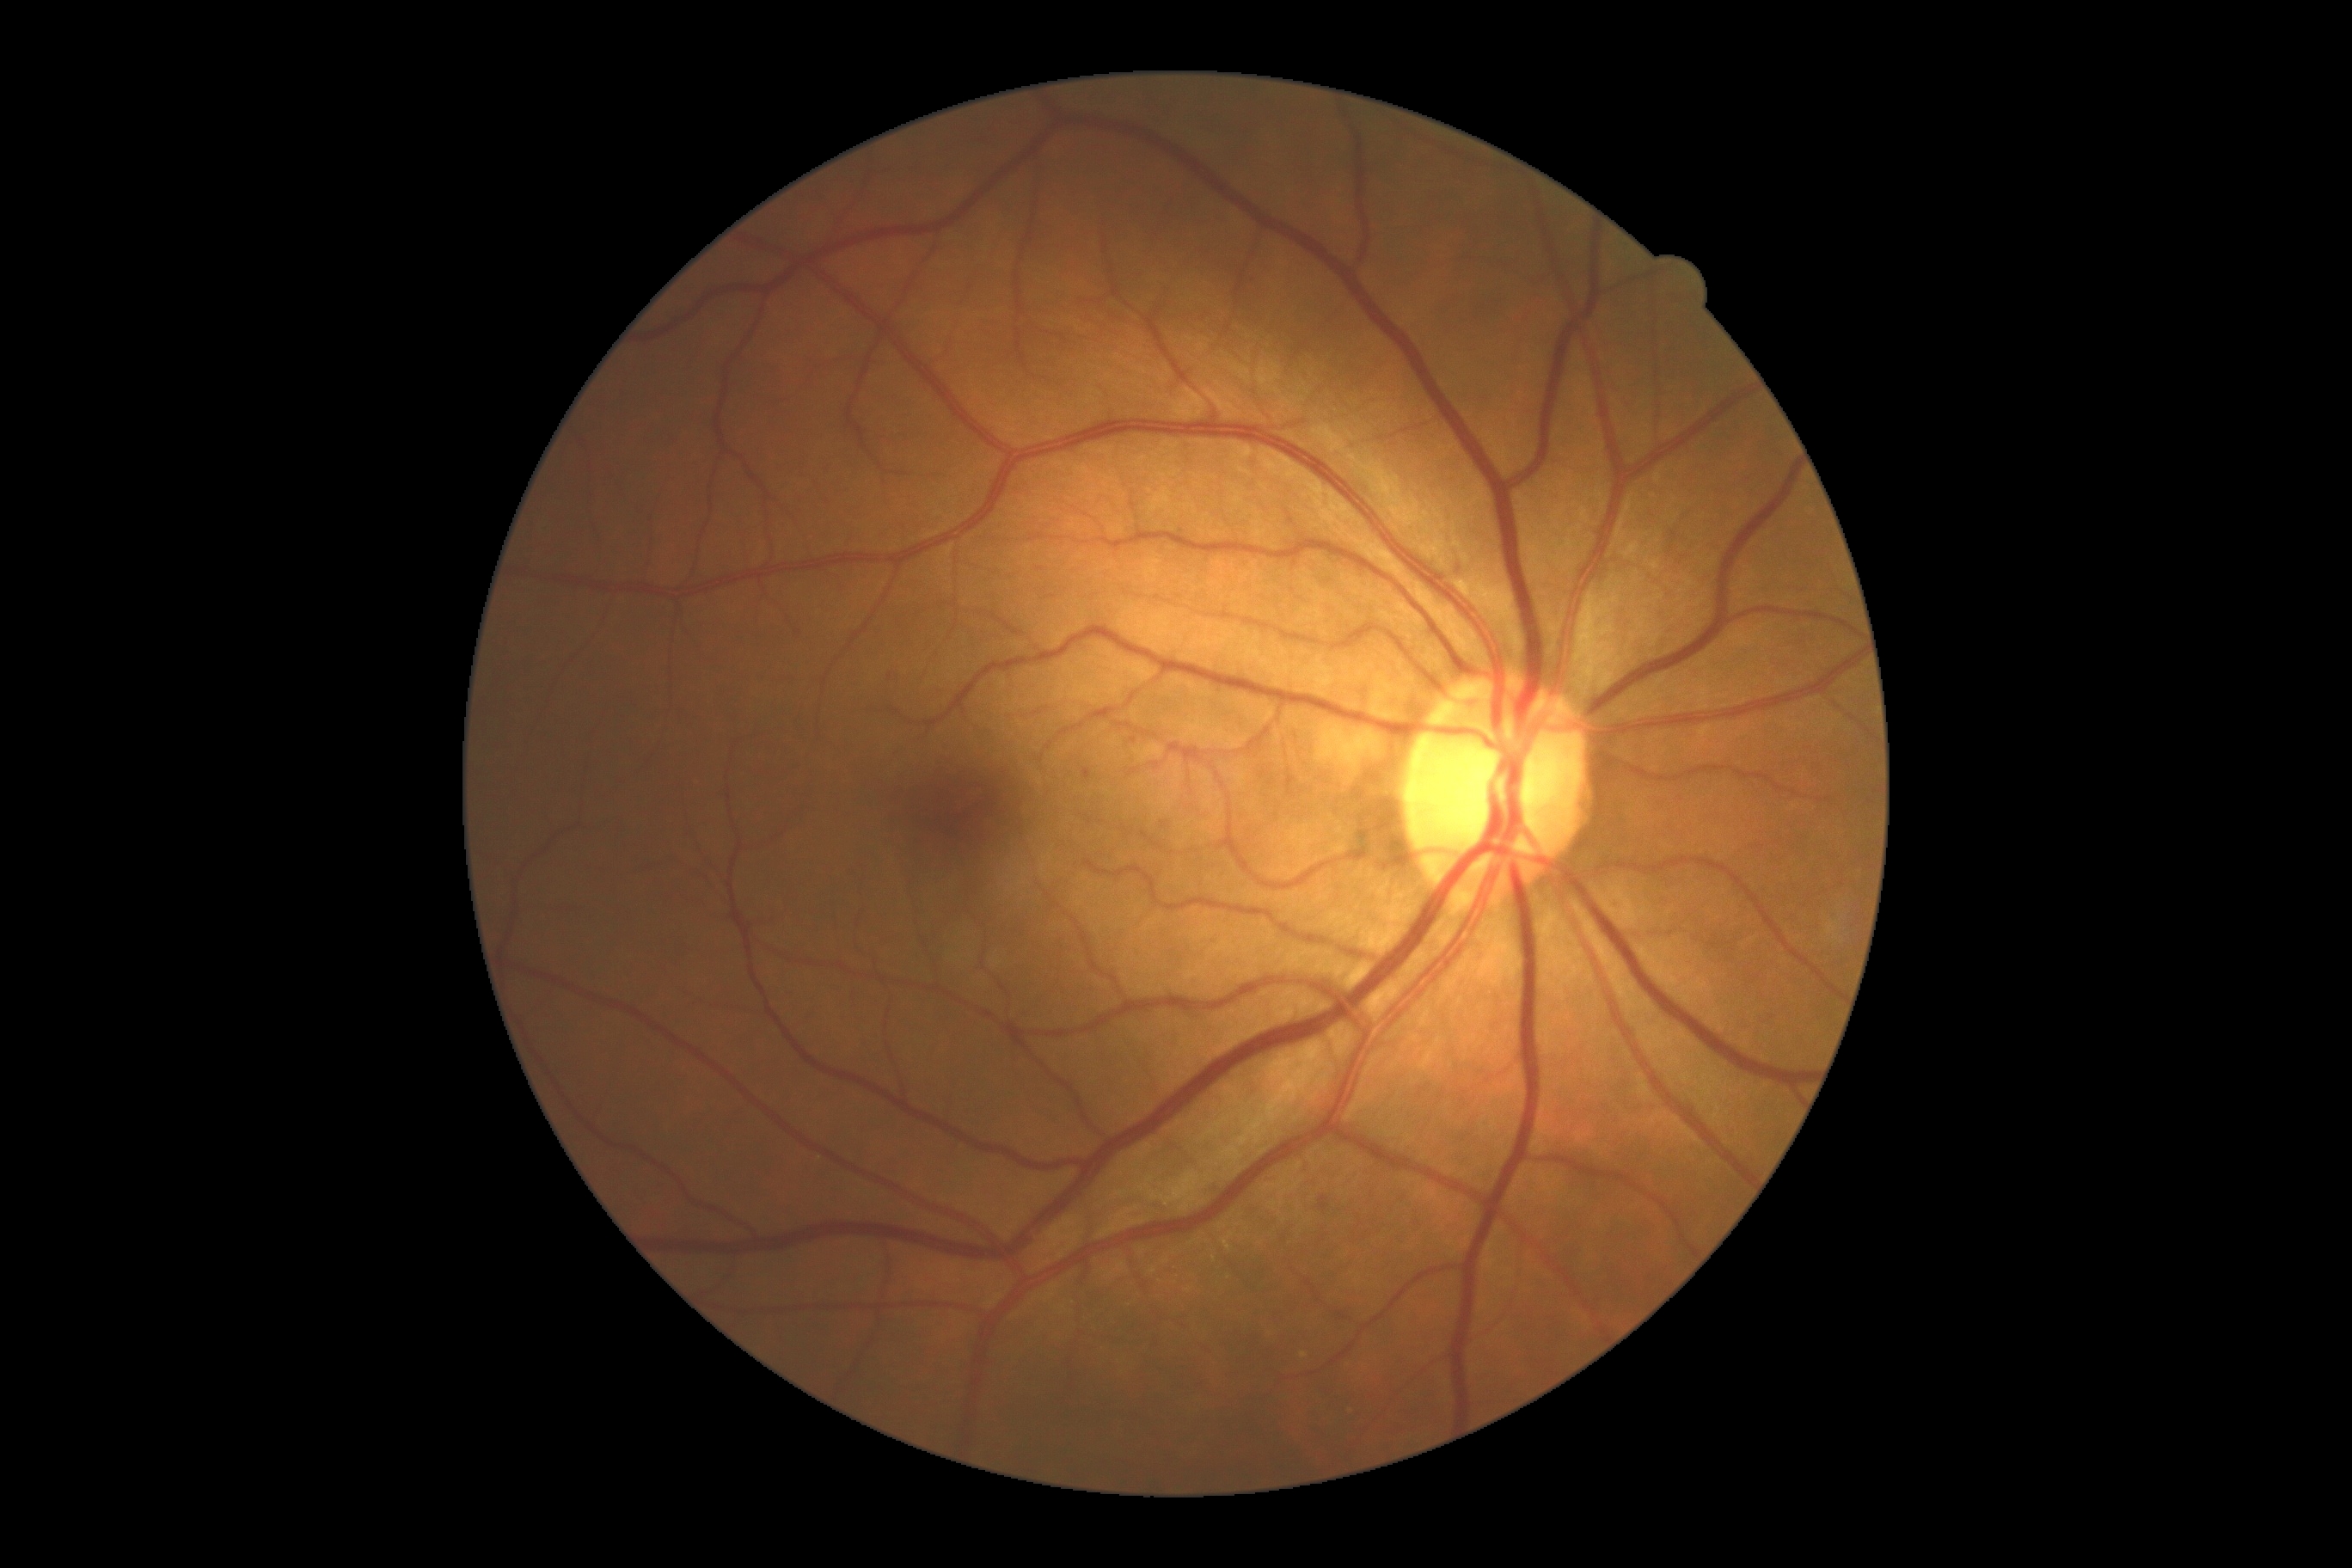

DR class: non-proliferative diabetic retinopathy.
Diabetic retinopathy (DR): mild NPDR (grade 1).